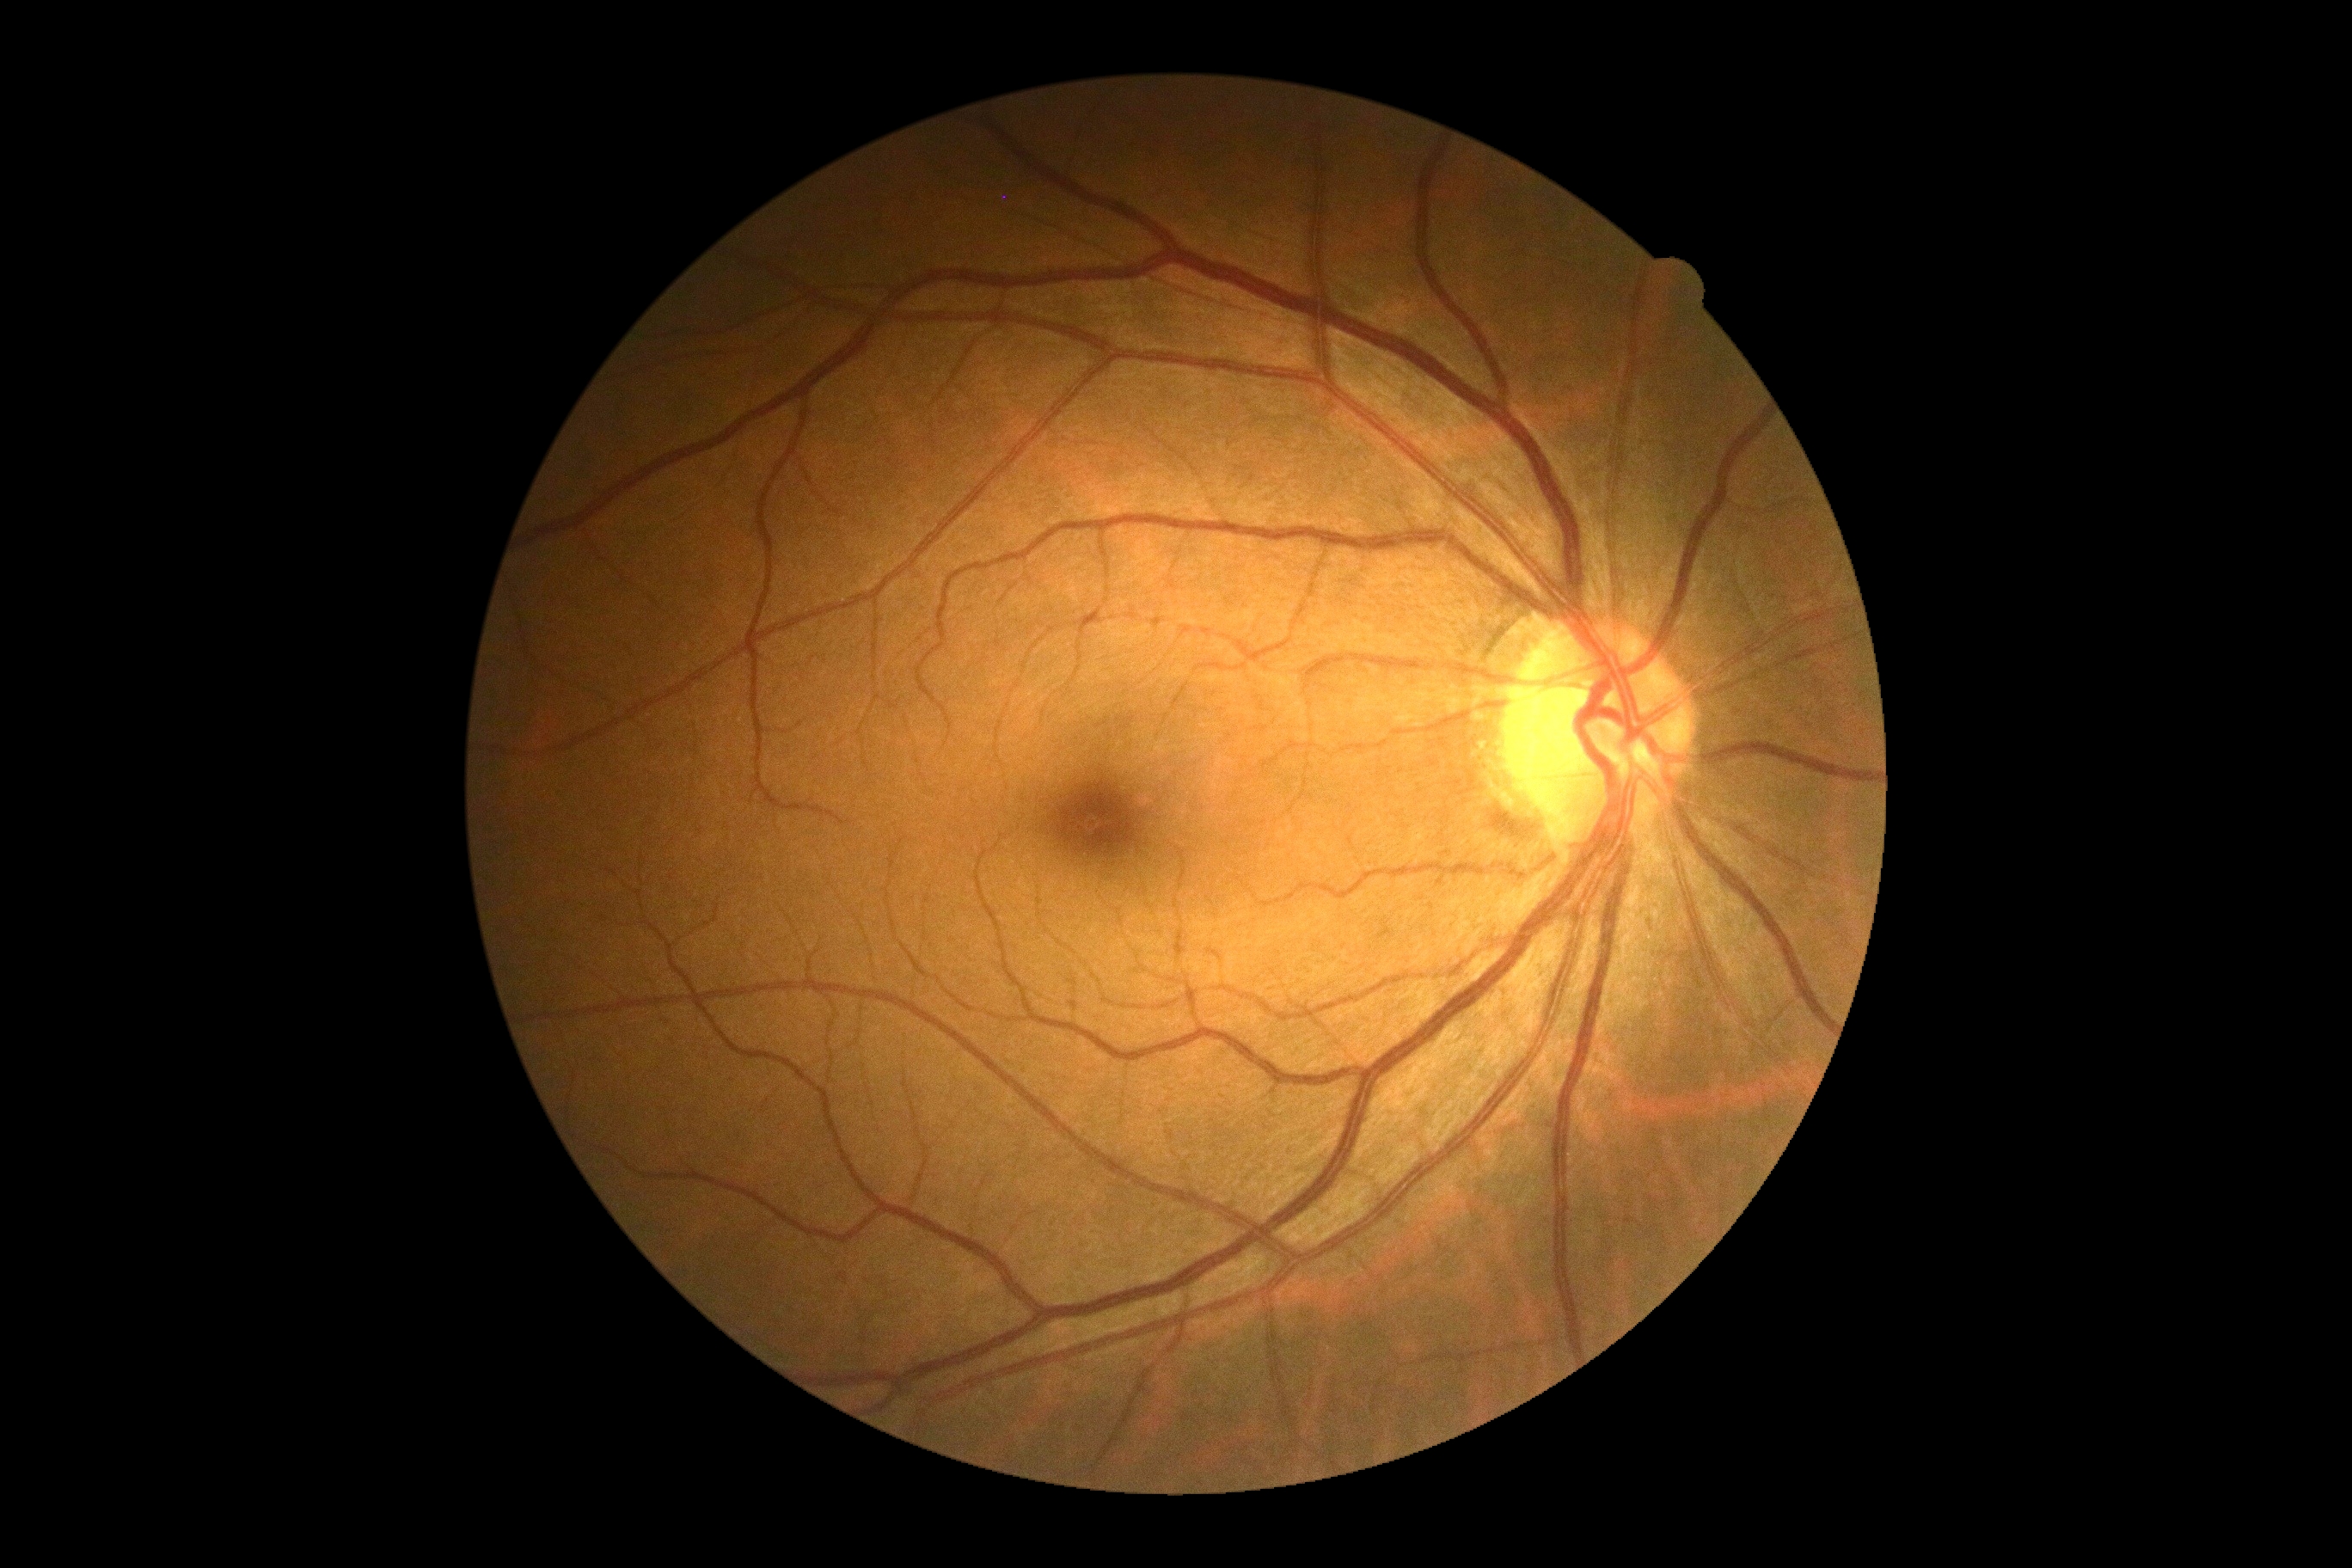 DR is 0.